1240 by 1240 pixels. Phoenix ICON wide-field infant fundus image — 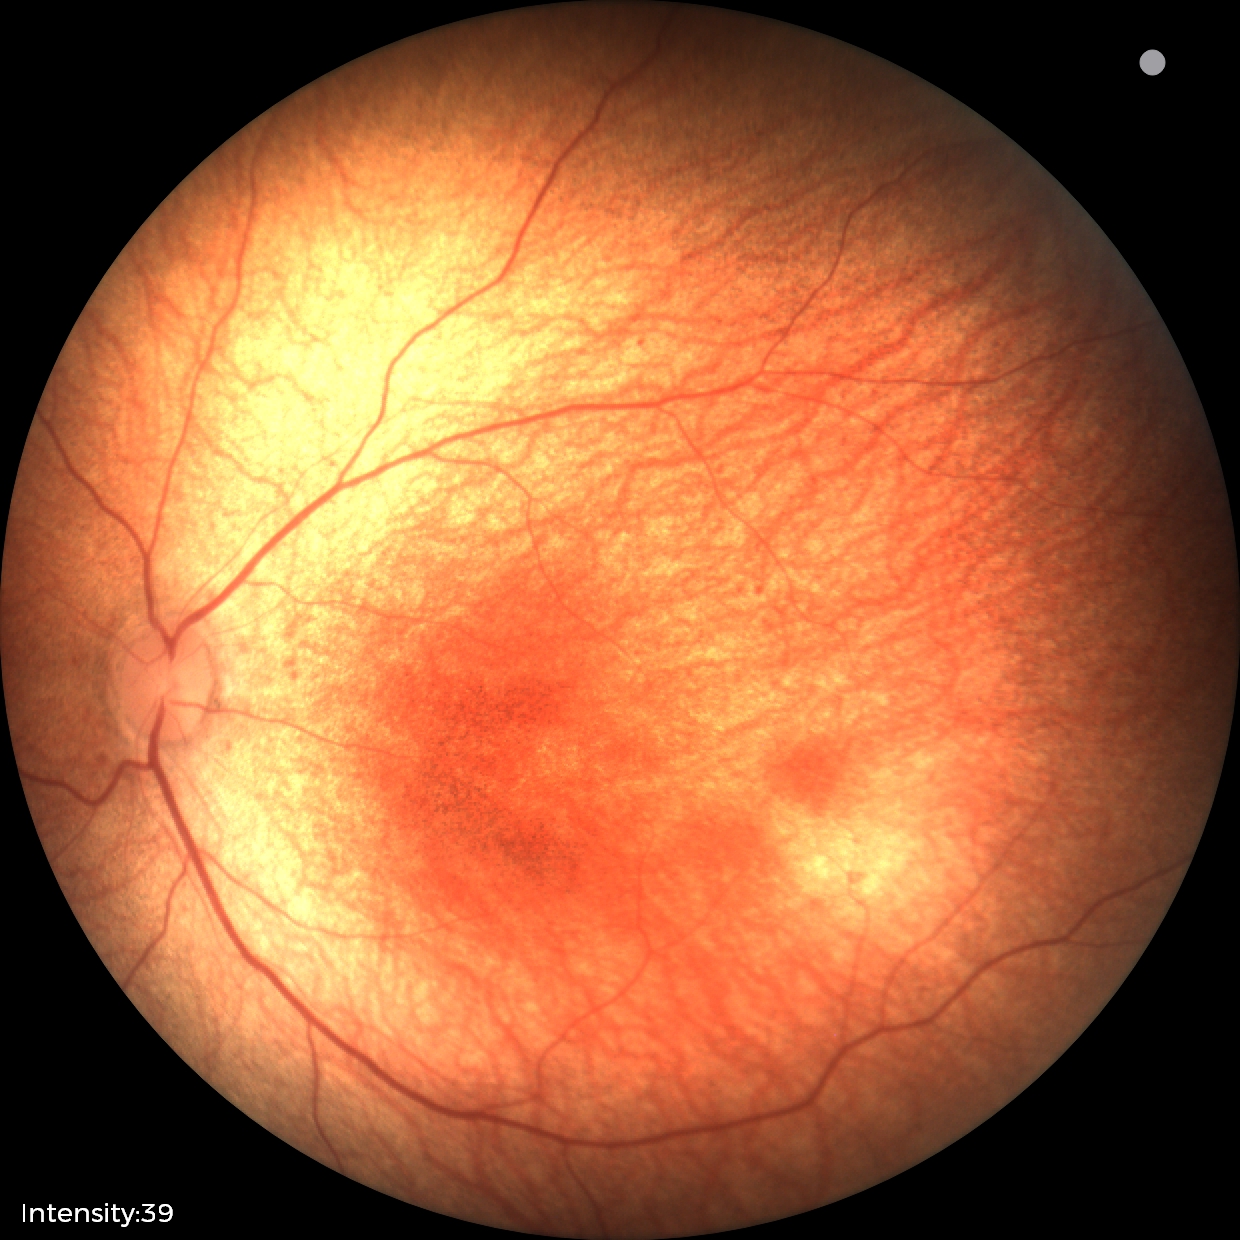

Normal screening examination.